1440x1080px · wide-field fundus photograph of an infant.
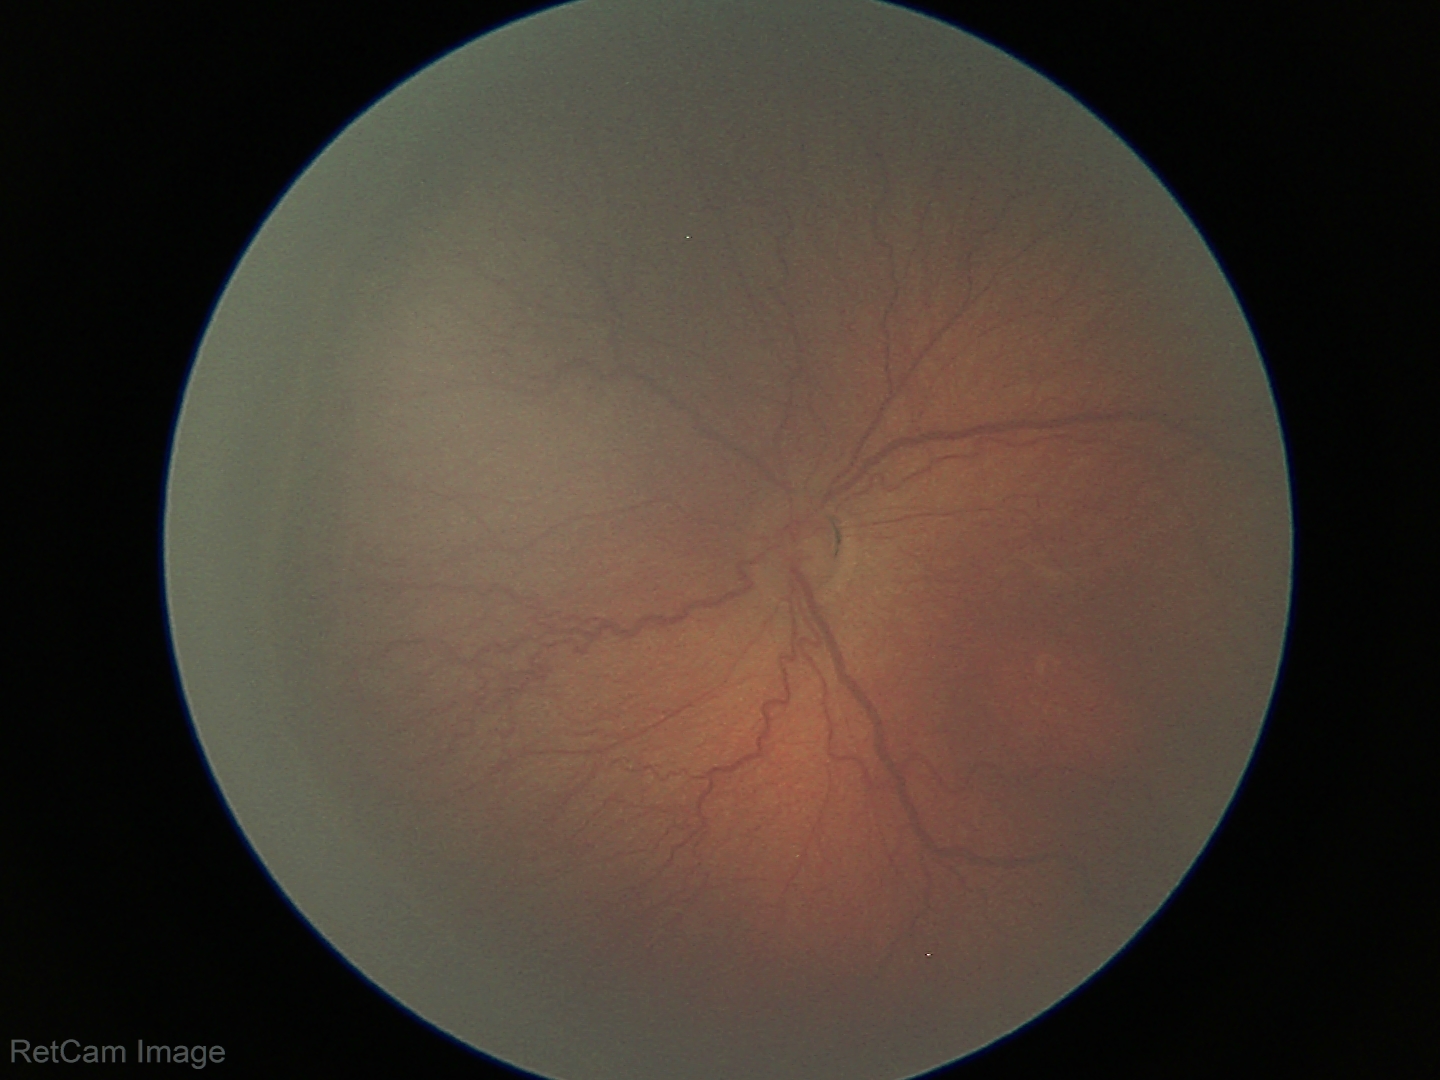

Screening series with retinopathy of prematurity stage 3. No plus disease.